Pediatric retinal photograph (wide-field); Clarity RetCam 3, 130° FOV:
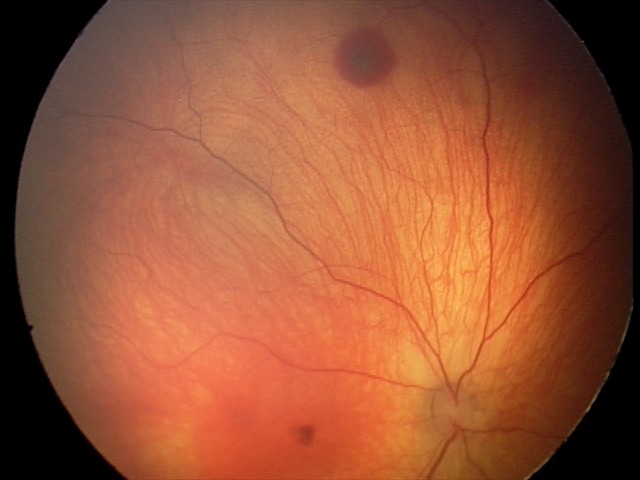
Examination diagnosed as retinal hemorrhages.